Fundus photo, 848 by 848 pixels
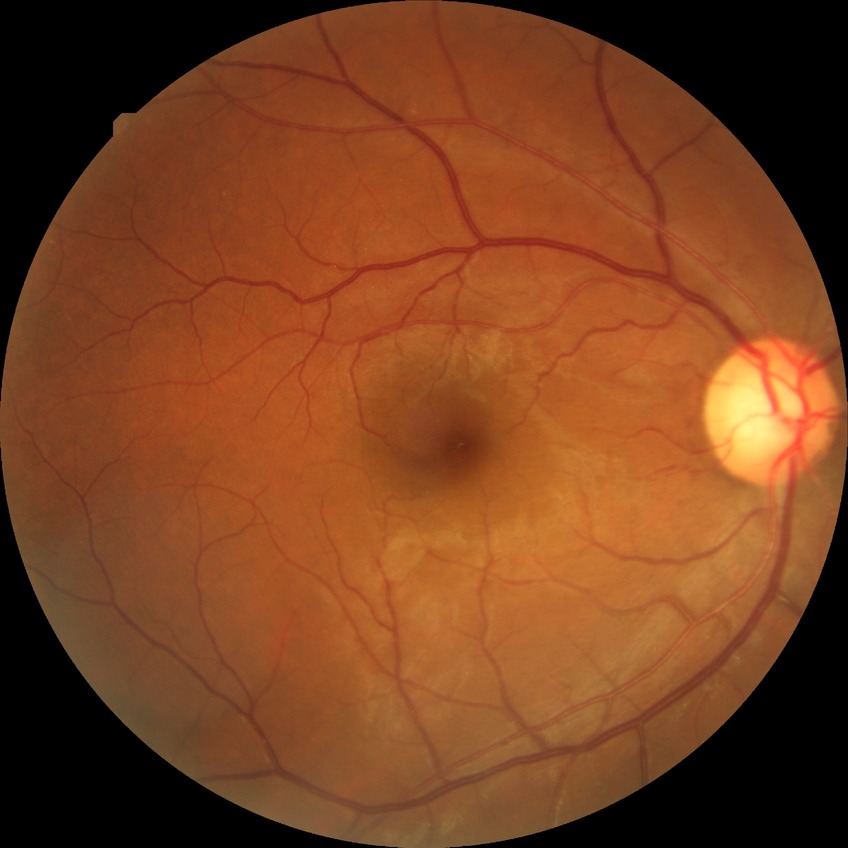 DR severity = NDR, DR impression = no signs of DR.